Acquired with a NIDEK AFC-230, image size 848x848, CFP, 45-degree field of view — 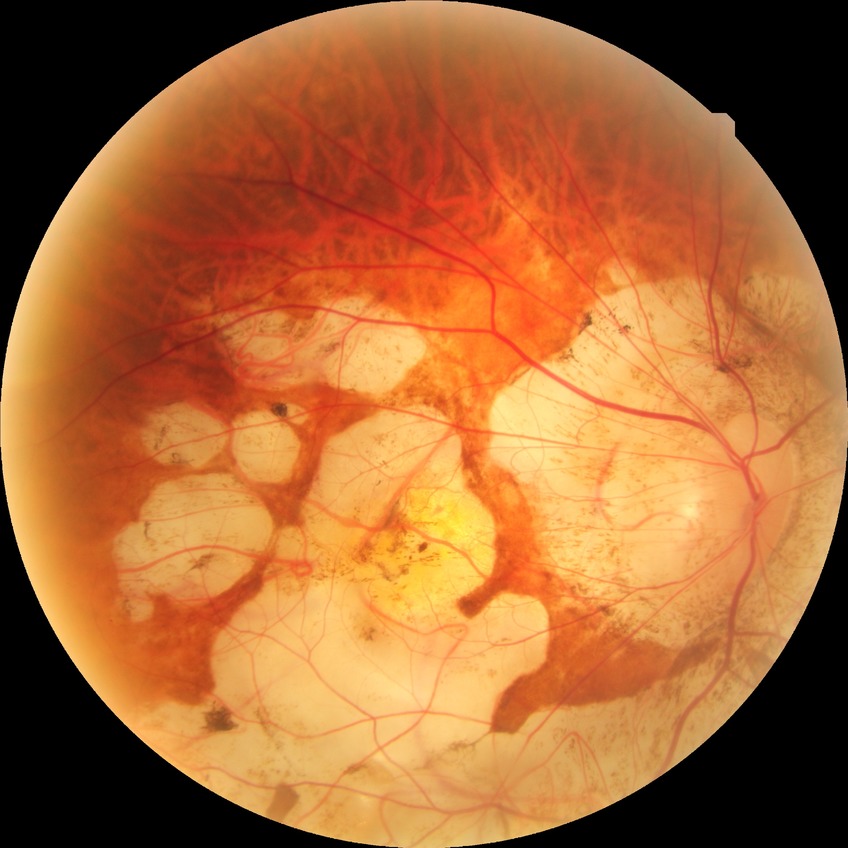

Diabetic retinopathy (DR): NDR (no diabetic retinopathy).